Wide-field fundus image from infant ROP screening. Acquired on the Phoenix ICON — 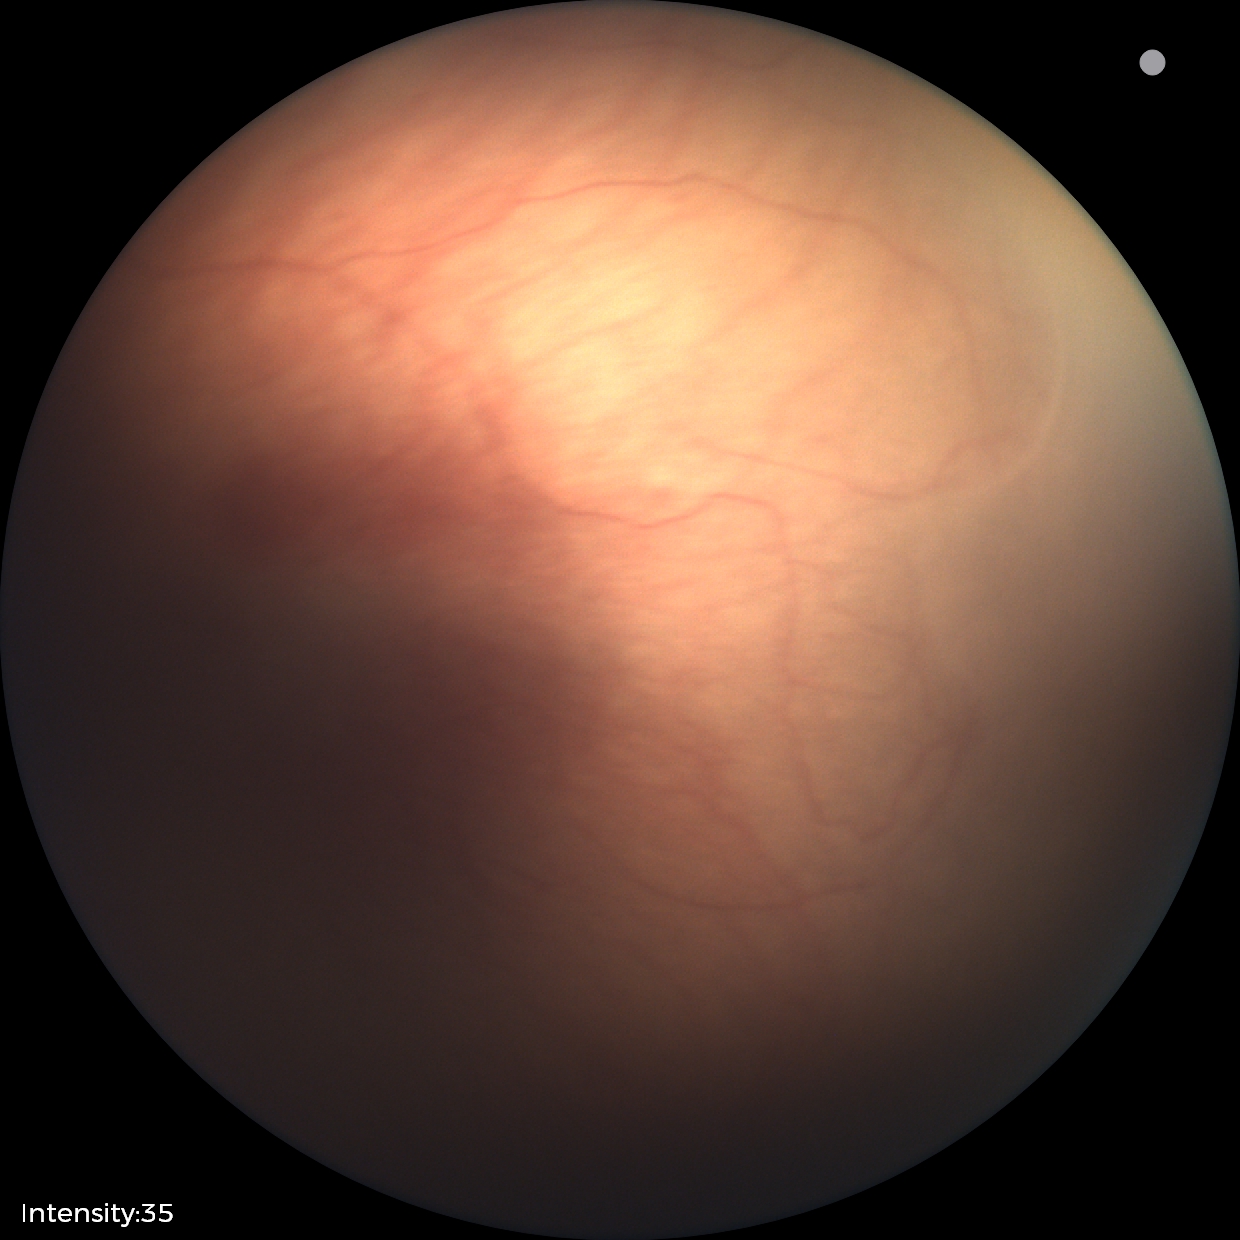 Assessment: retinopathy of prematurity (ROP) stage 1; no plus disease.